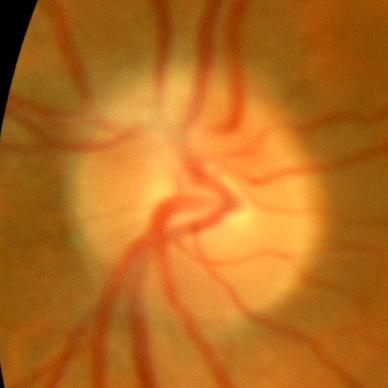 Demonstrates no glaucoma.